FOV: 45 degrees — 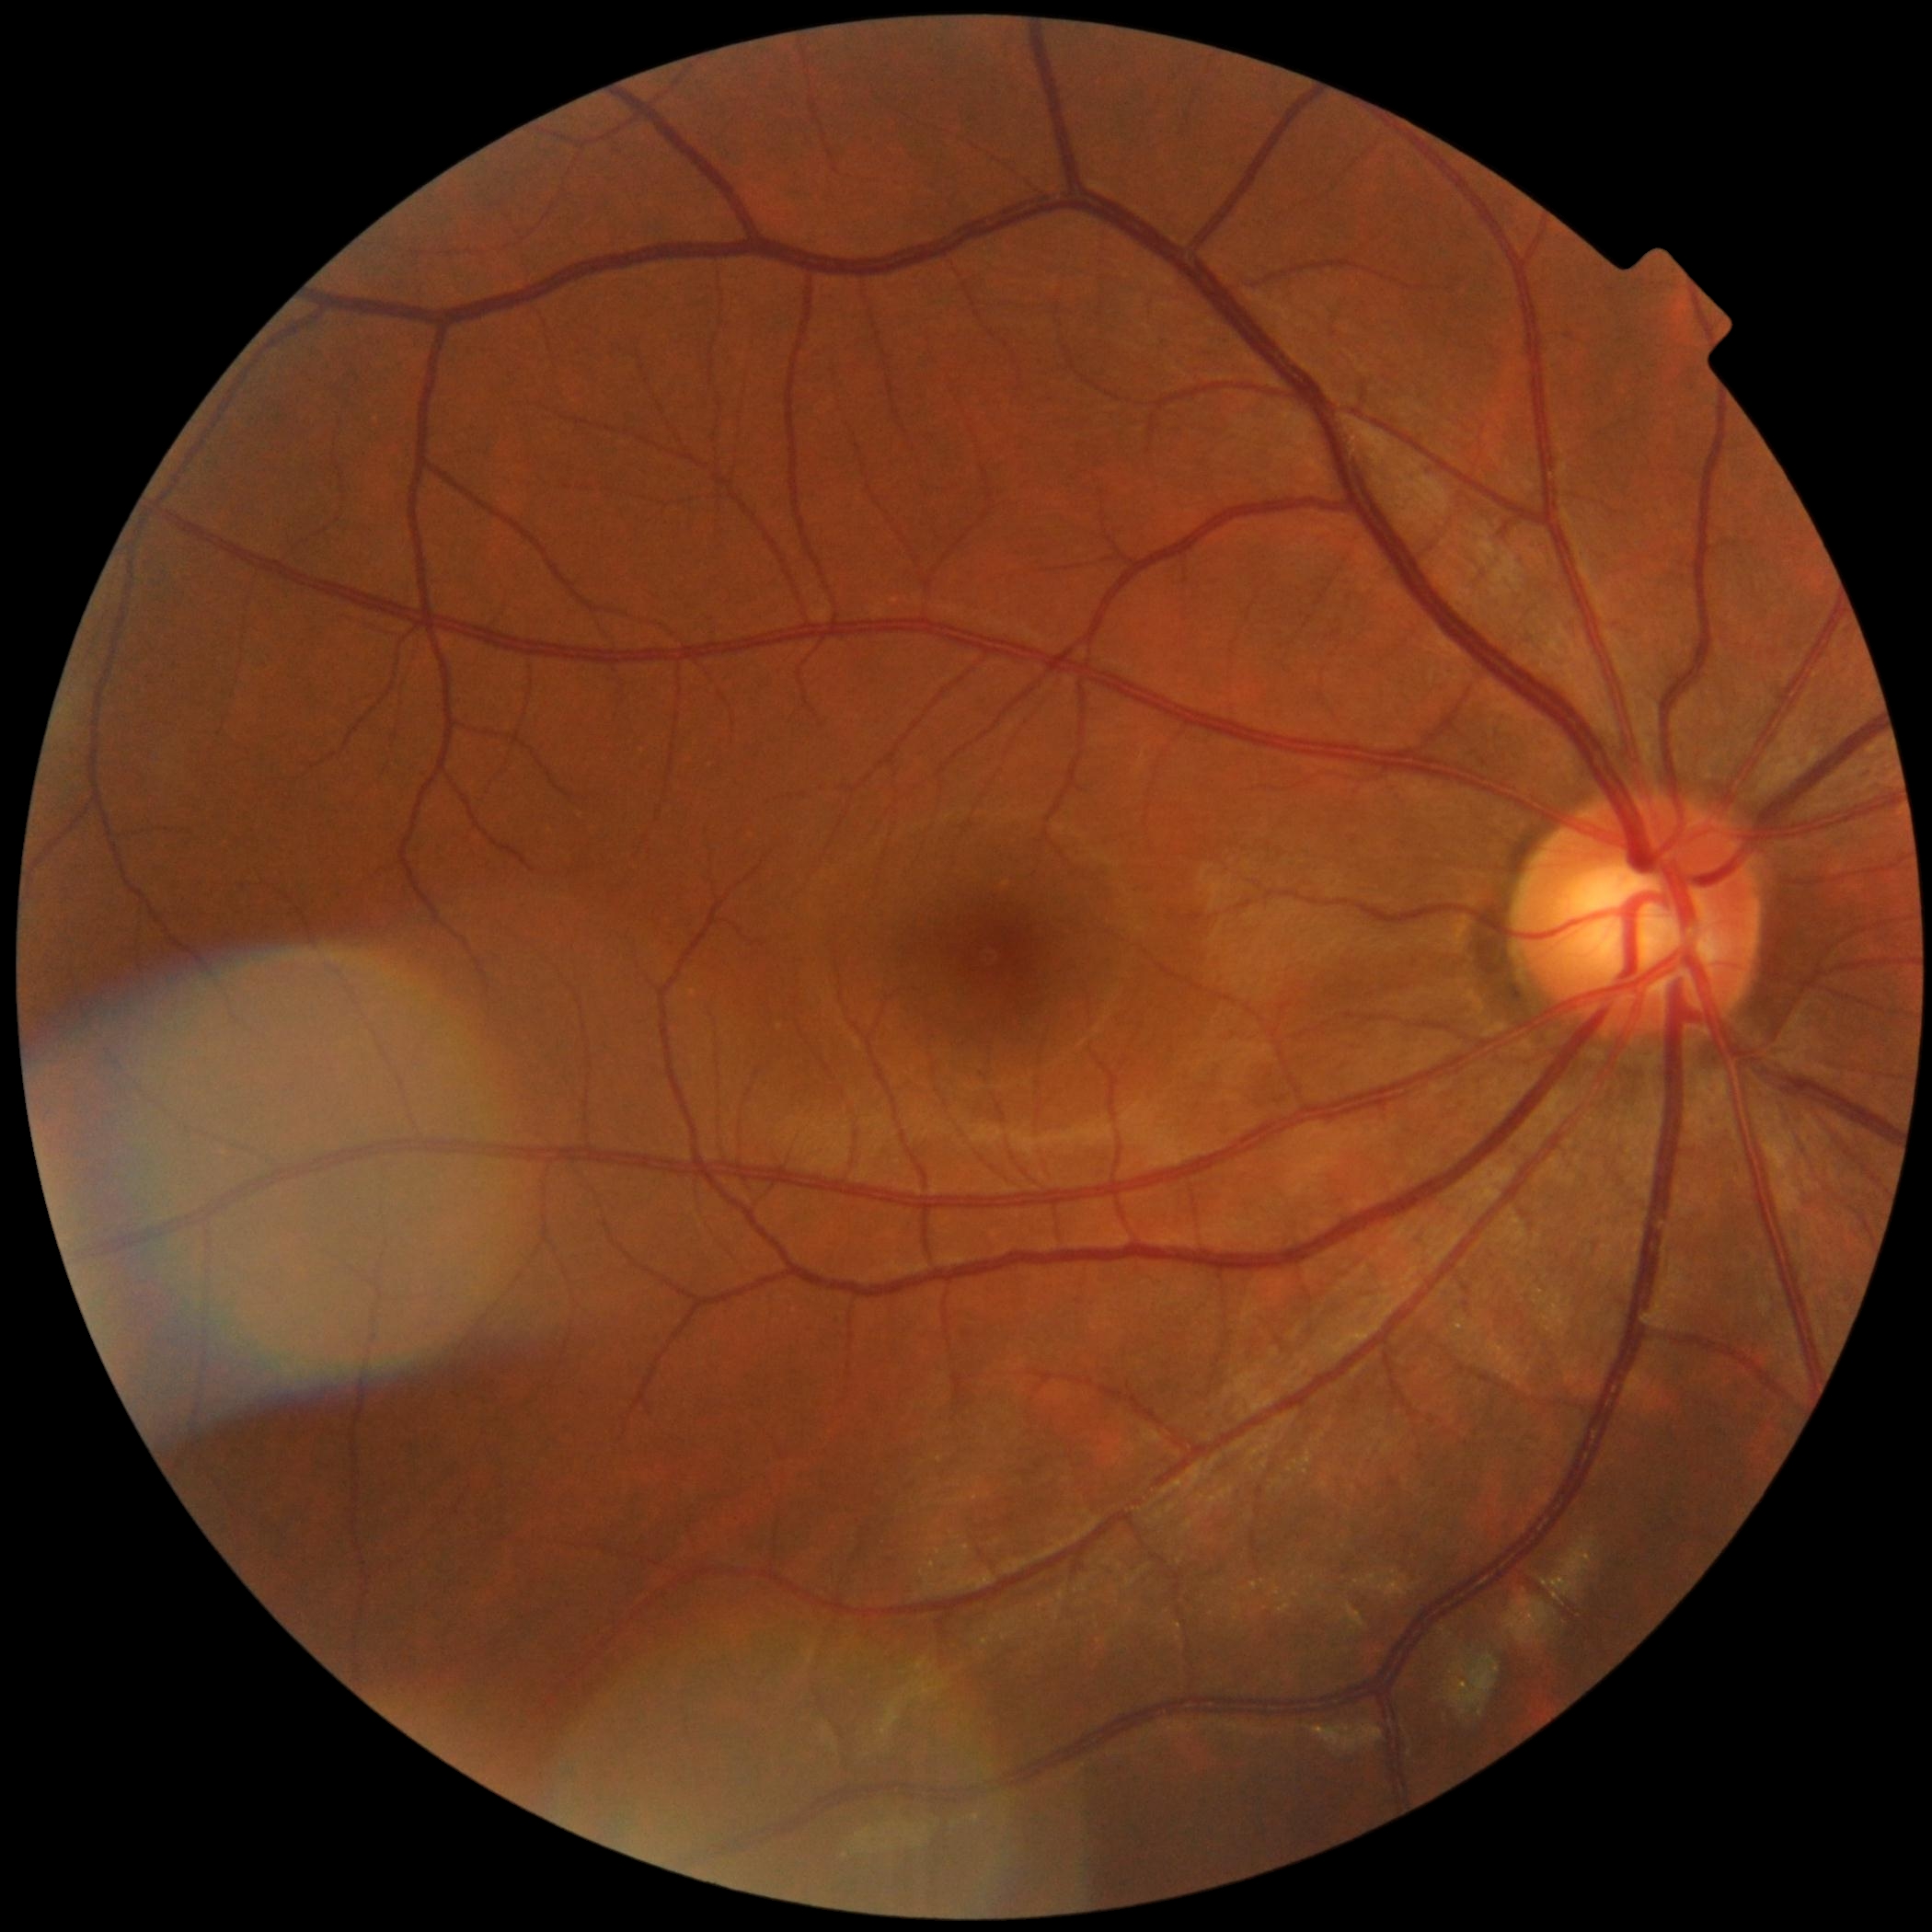
diabetic retinopathy (DR) = 0 — no visible signs of diabetic retinopathy.